CFP:
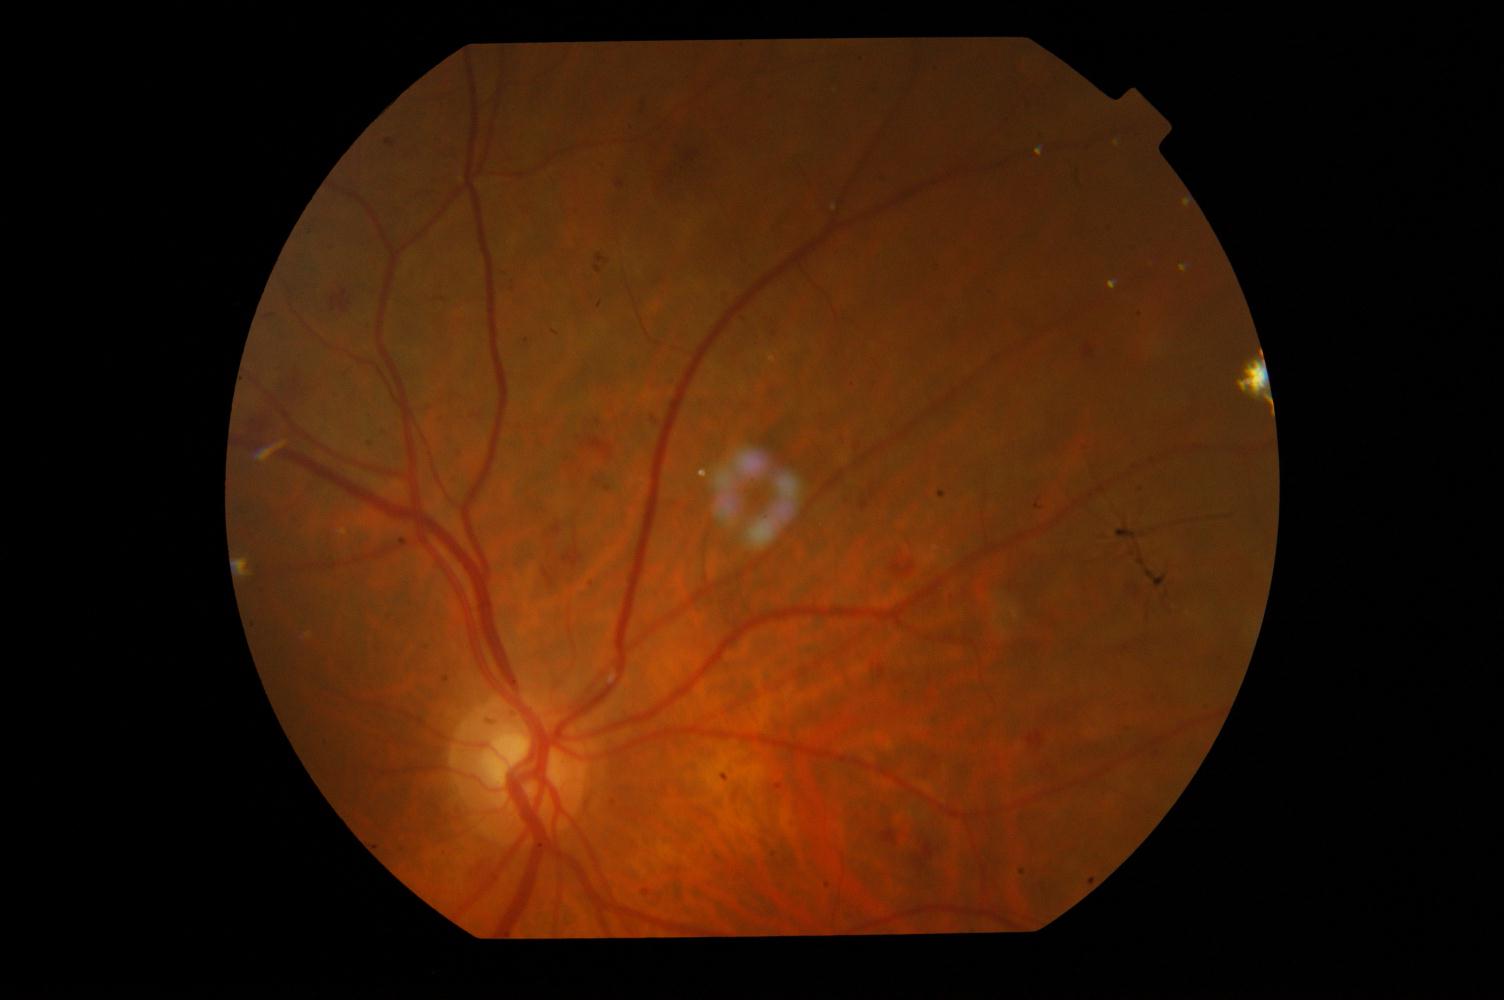
Showing diabetic retinopathy (DR).